Modified Davis grading, no pharmacologic dilation.
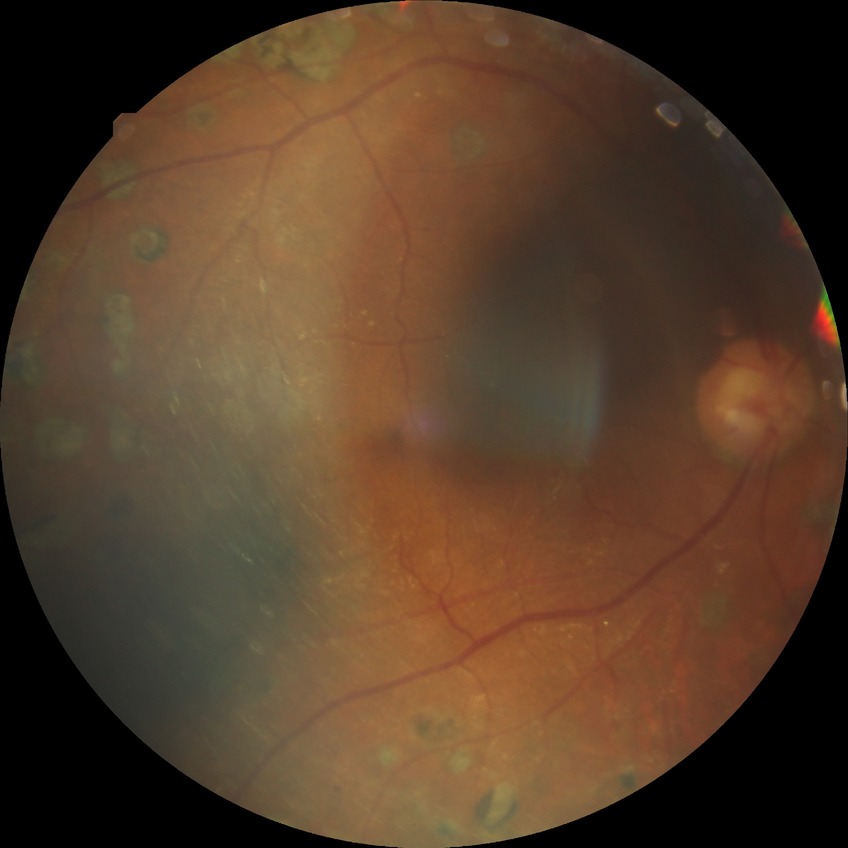

Diabetic retinopathy (DR): PDR (proliferative diabetic retinopathy).